Color fundus photograph; posterior pole field covering the optic disc and macula; 50° FOV; acquired with a Topcon TRC-50DX — 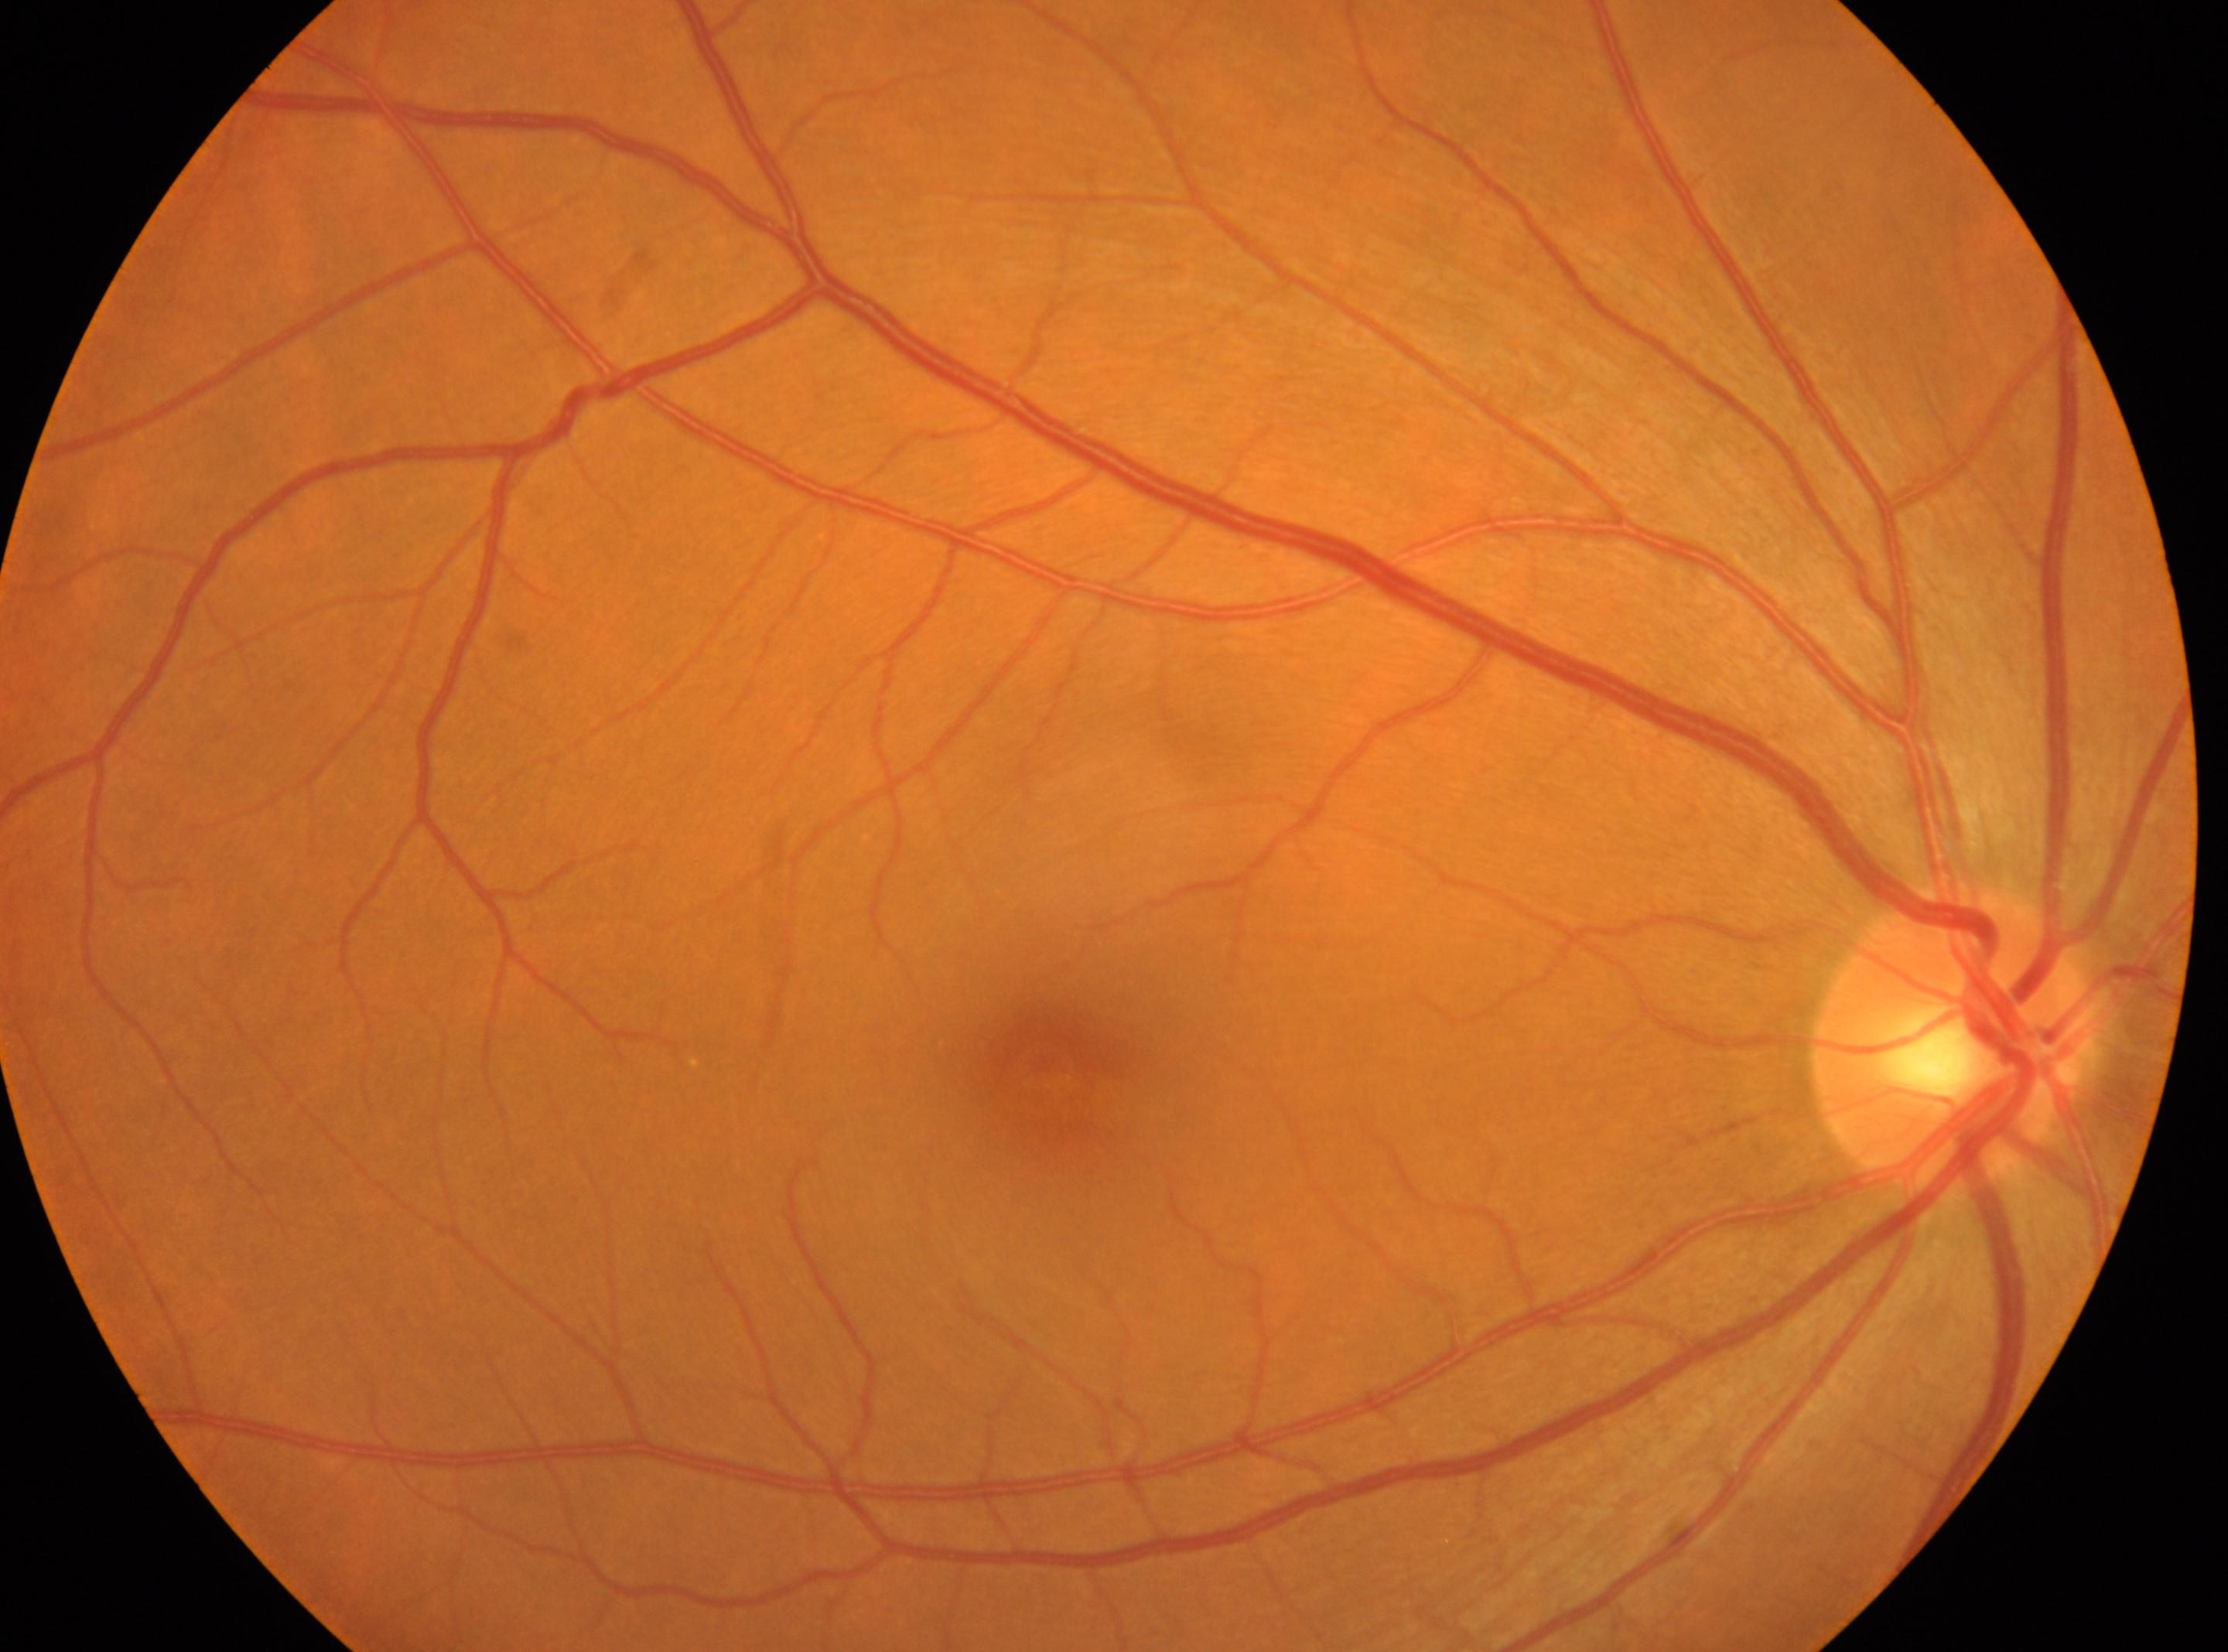   eye: right
  dr_grade: 0
  optic_disc: [1951, 1039]
  fovea: [1043, 1063]
  dr_impression: No DR findings